Mydriatic (tropicamide and phenylephrine), CFP, captured on a Topcon TRC-50DX fundus camera — 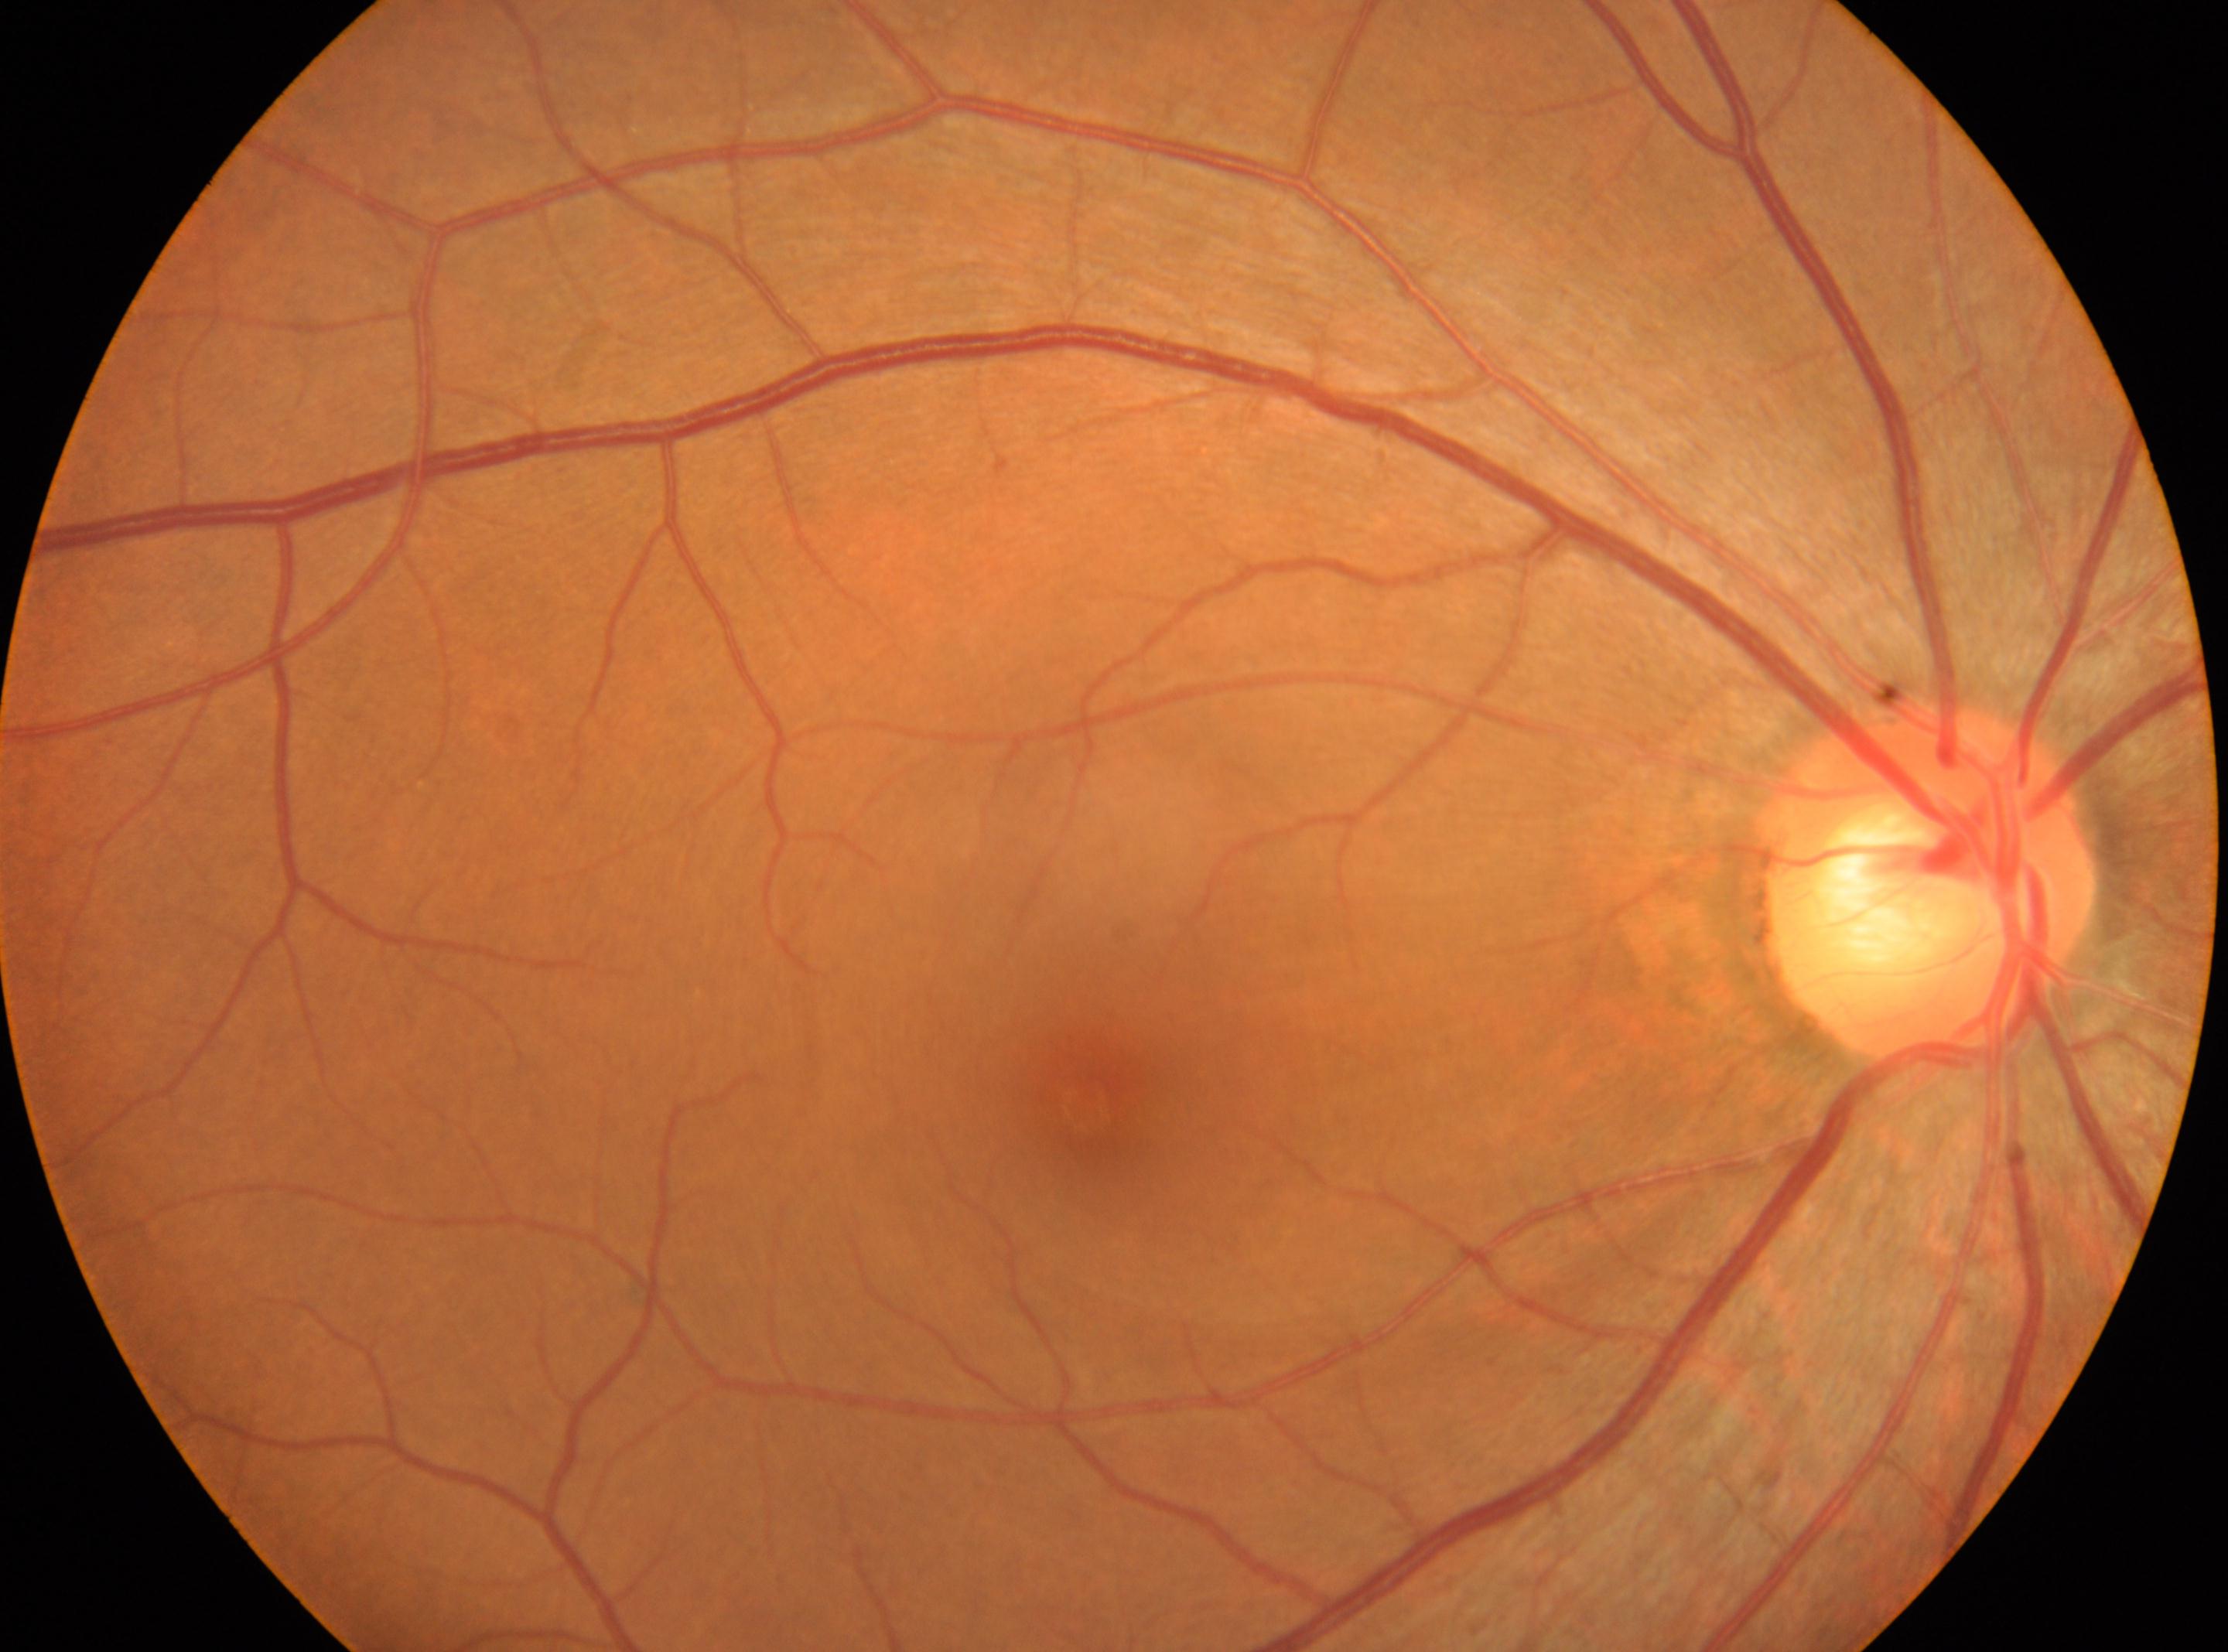 Disc center: (x=1932, y=882).
Retinopathy grade is 0 — no visible signs of diabetic retinopathy.
Imaged eye: right.
The fovea is at (x=1092, y=1106).
No diabetic retinal disease findings.